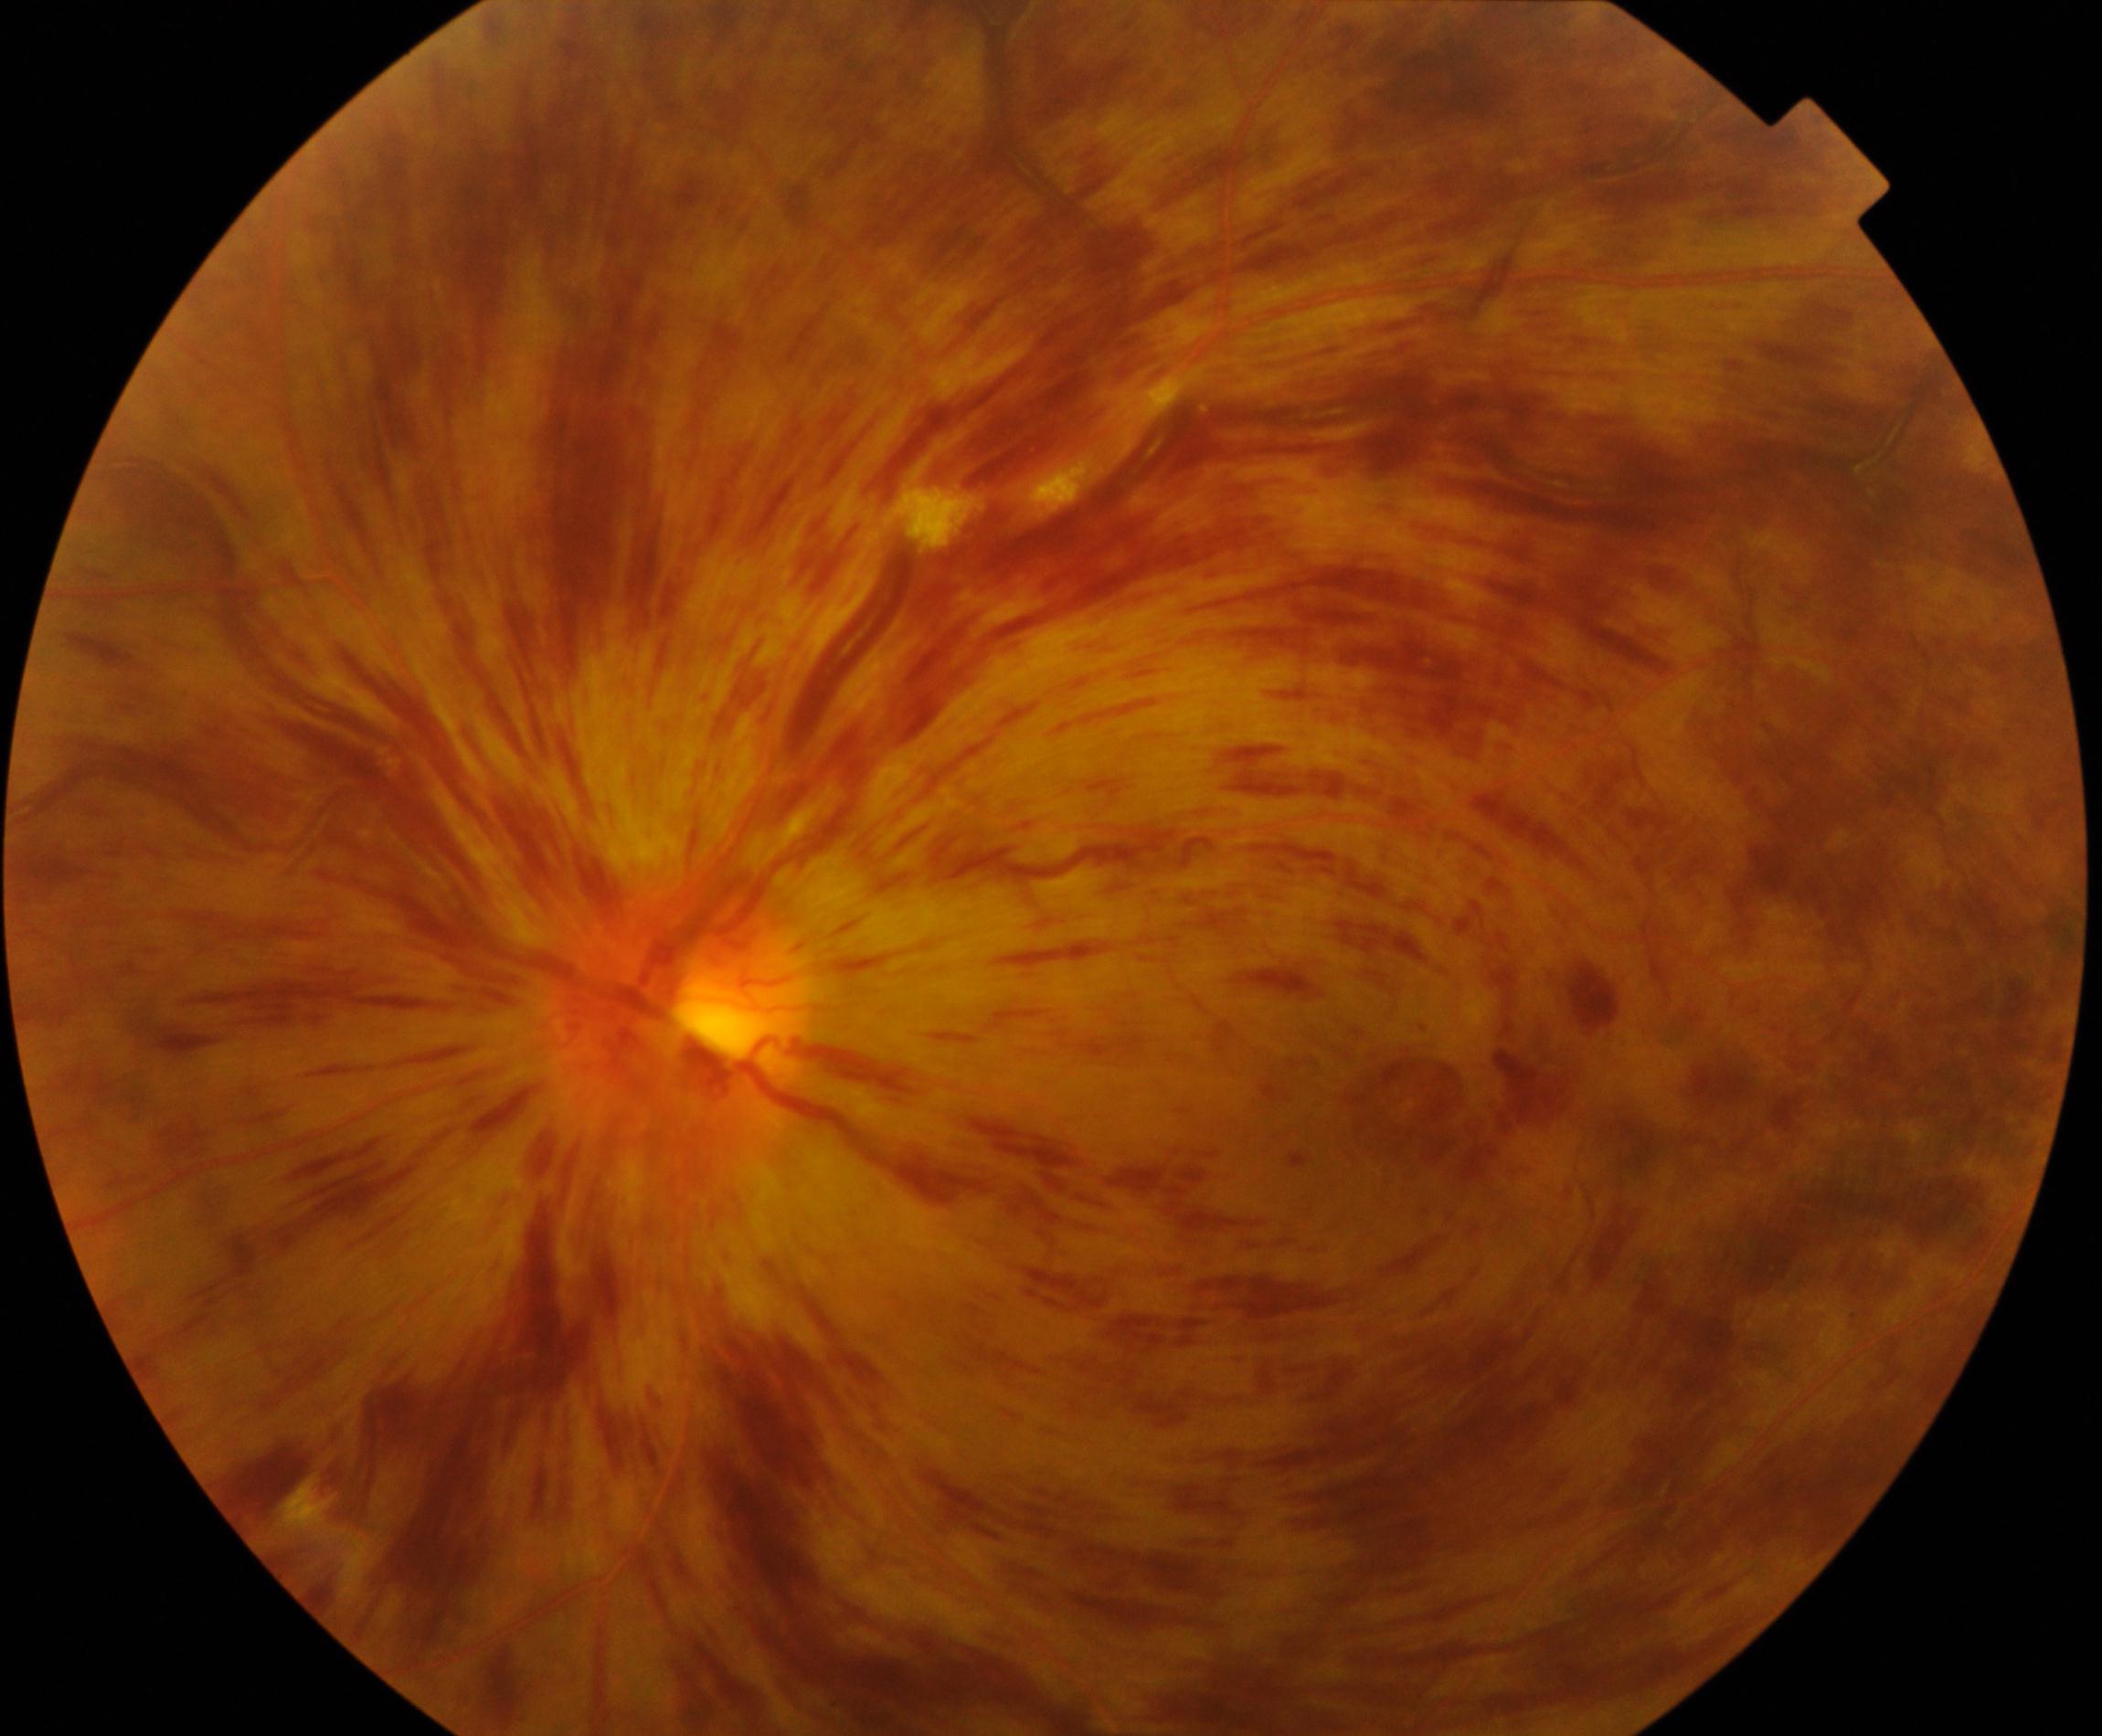
Fundus image consistent with CRVO (central retinal vein occlusion).